Wide-field contact fundus photograph of an infant
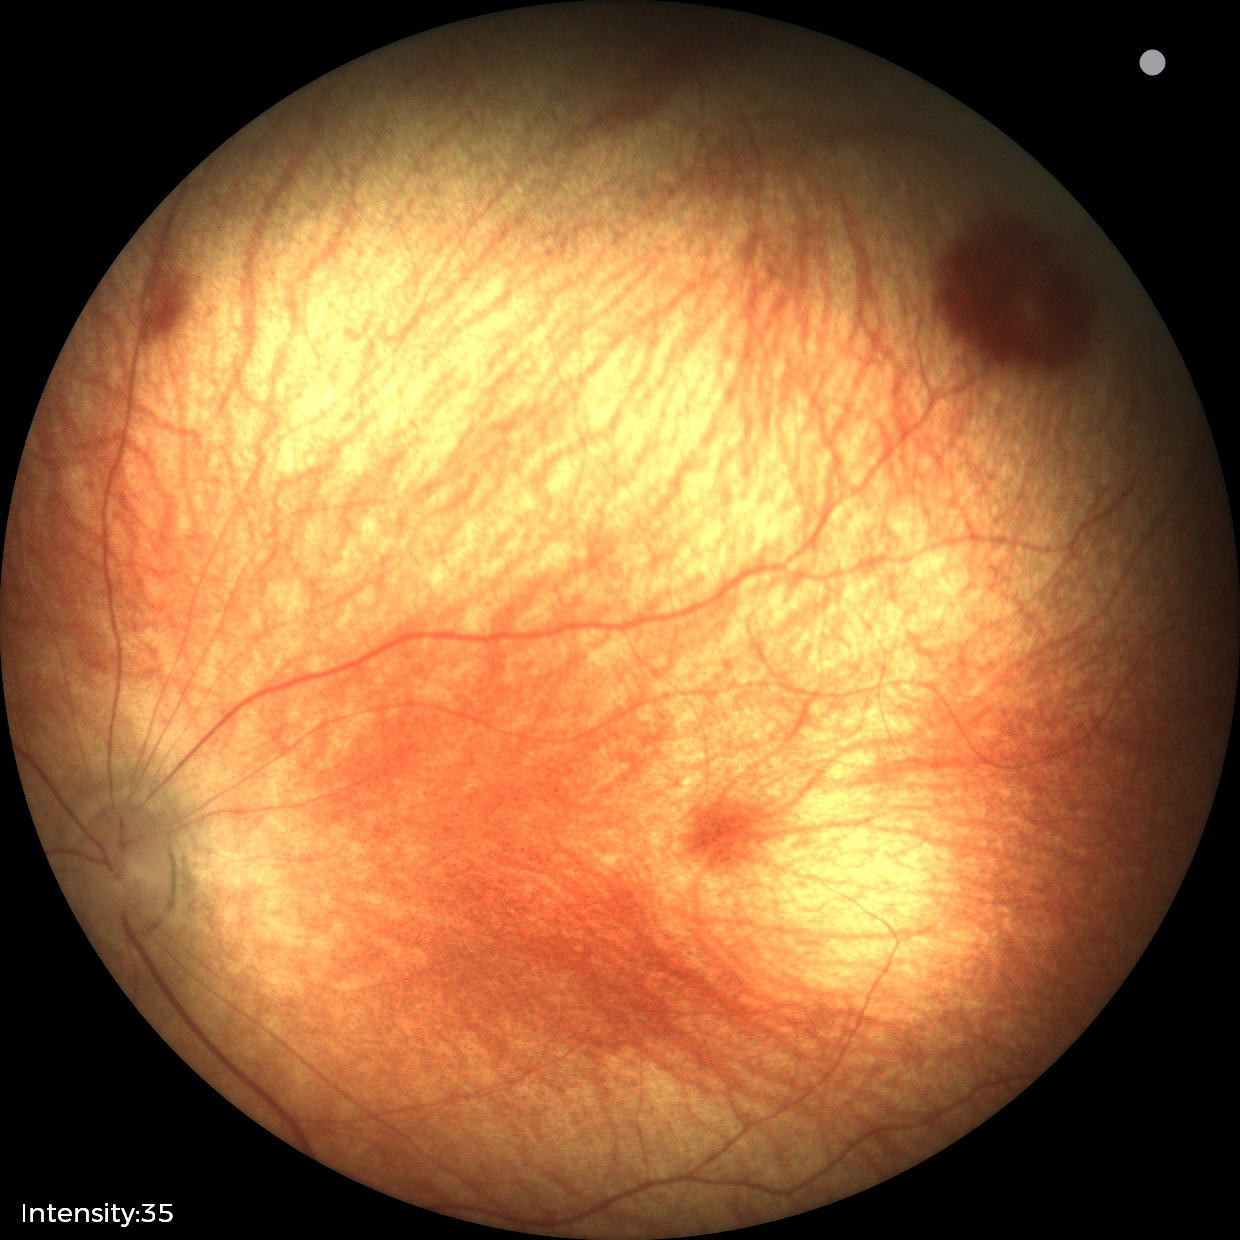 Examination diagnosed as retinal hemorrhages.